45-degree field of view; color fundus photograph; 2048x1536px.
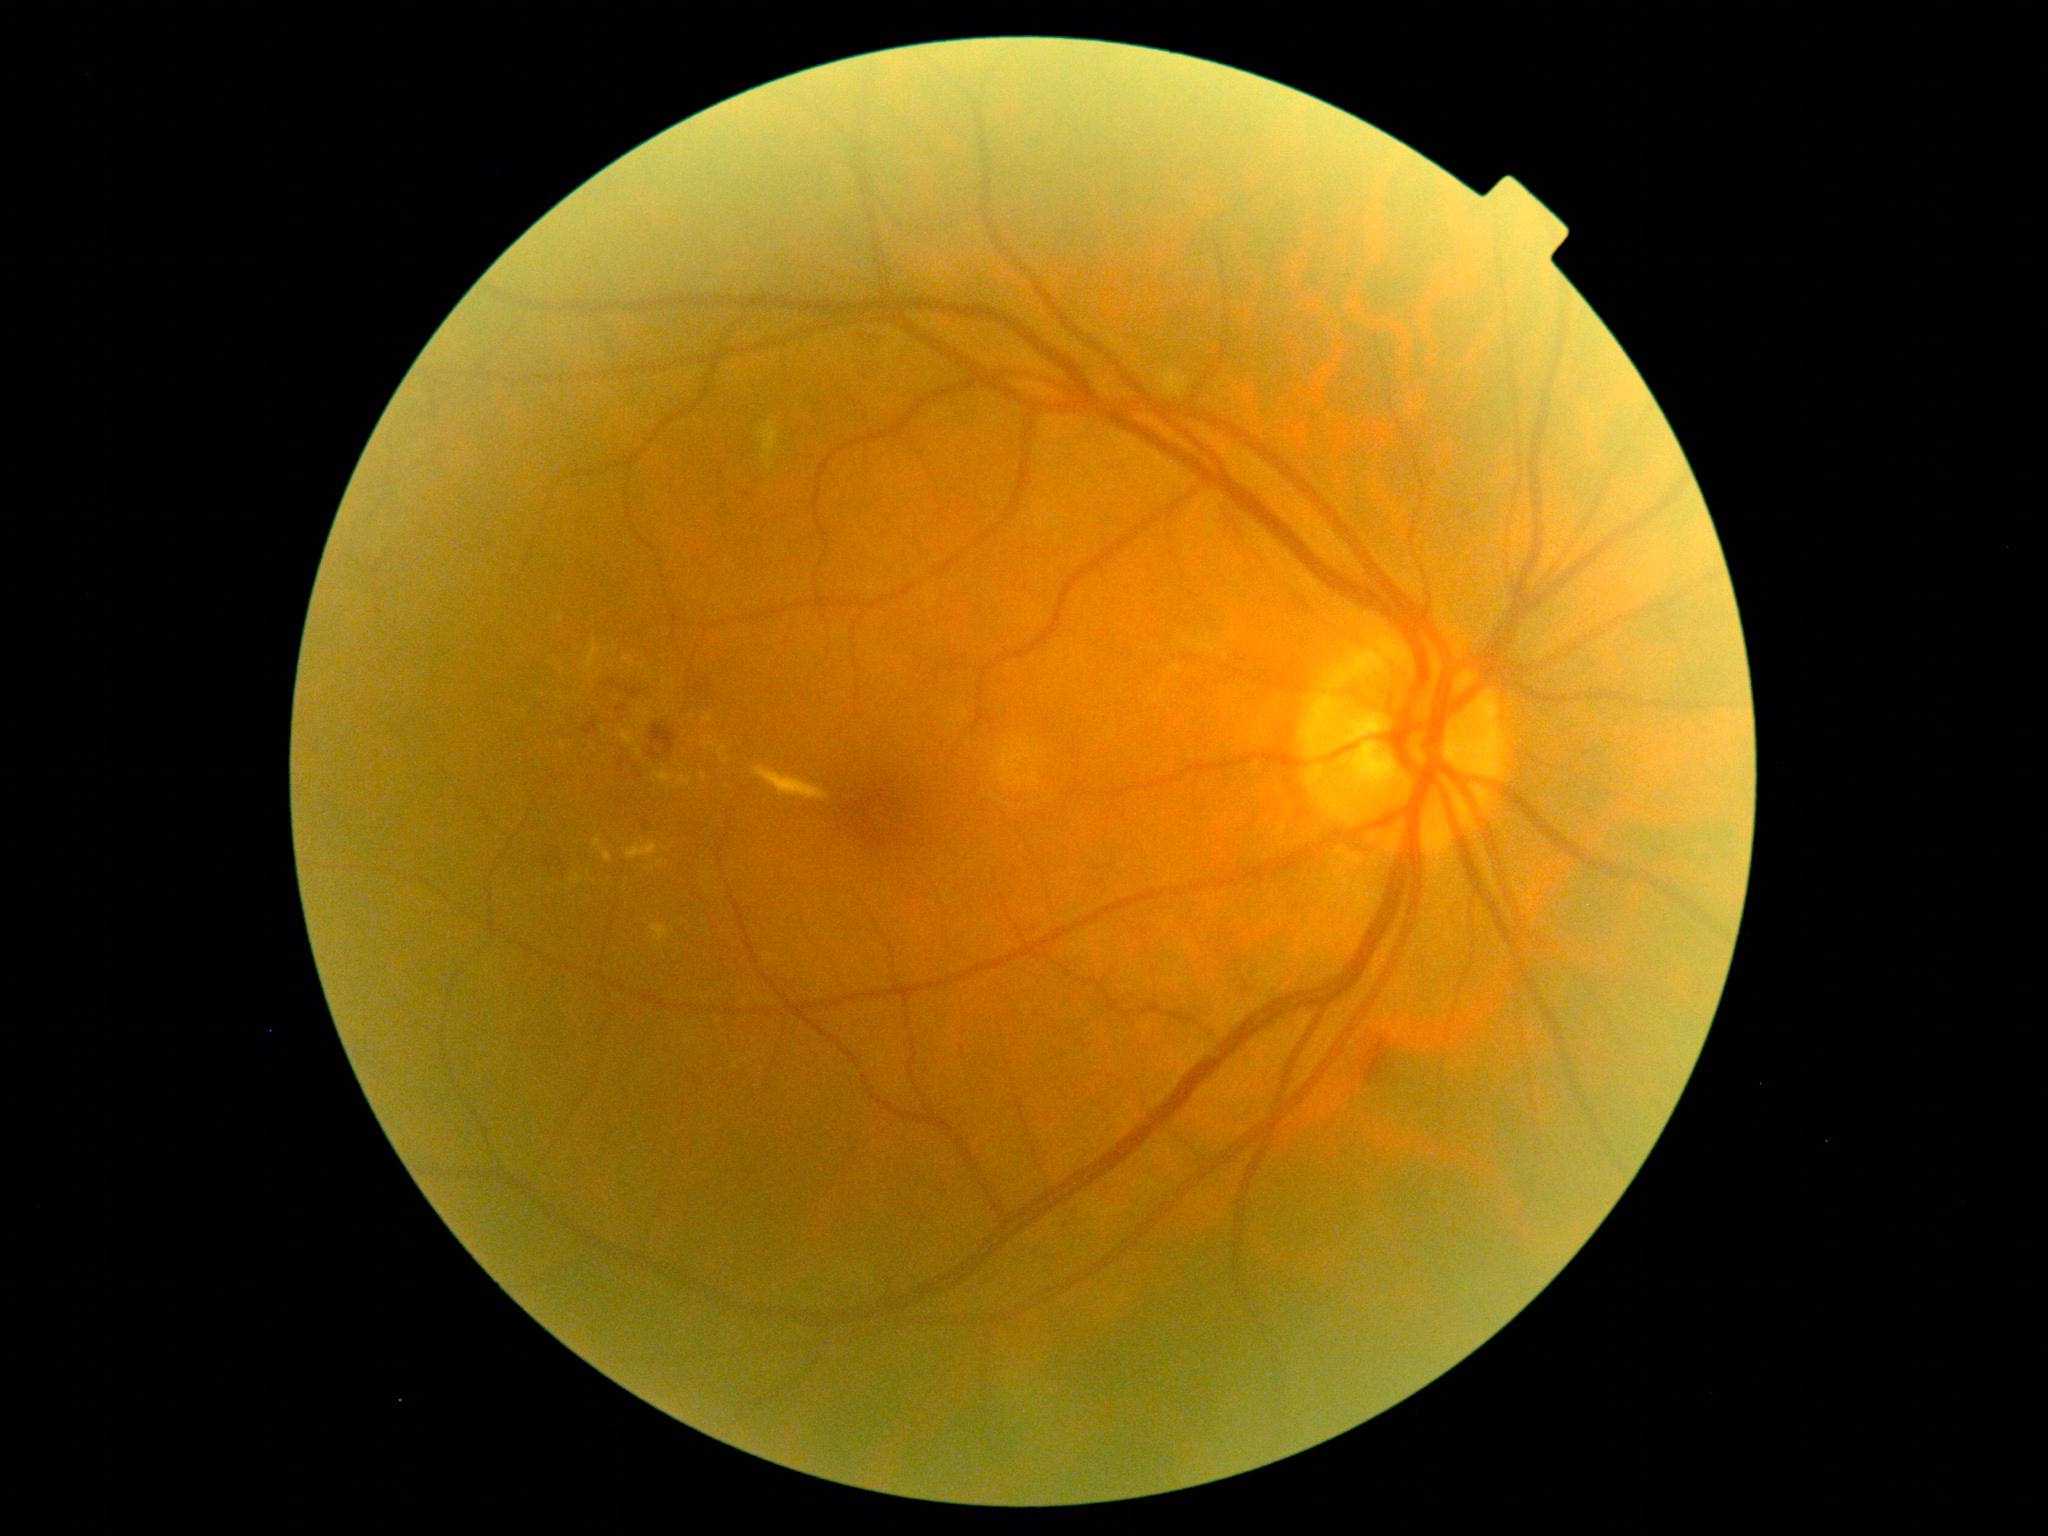

<lesions partial="true">
  <dr_grade>2</dr_grade>
  <ex partial="true"><box>627,842,658,860</box>; <box>703,737,717,751</box>; <box>585,641,601,668</box>; <box>647,671,657,678</box>; <box>677,776,693,787</box>; <box>700,773,707,781</box></ex>
  <ex_small_centers>(632,664); (563,699); (727,787); (692,742); (708,891); (648,870); (604,731); (693,717); (665,957)</ex_small_centers>
</lesions>